640x480 · acquired on the Clarity RetCam 3 · wide-field fundus image from infant ROP screening.
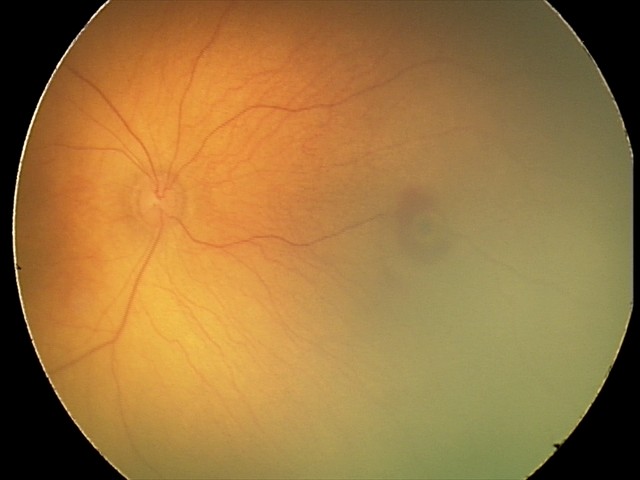

Examination diagnosed as retinal hemorrhages.